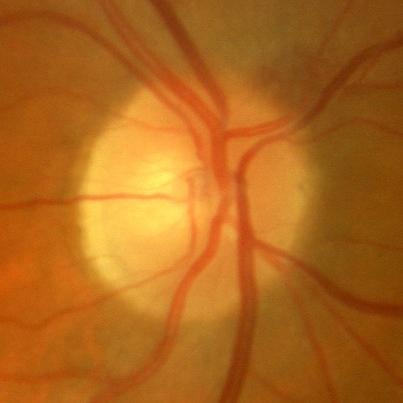

No glaucoma.